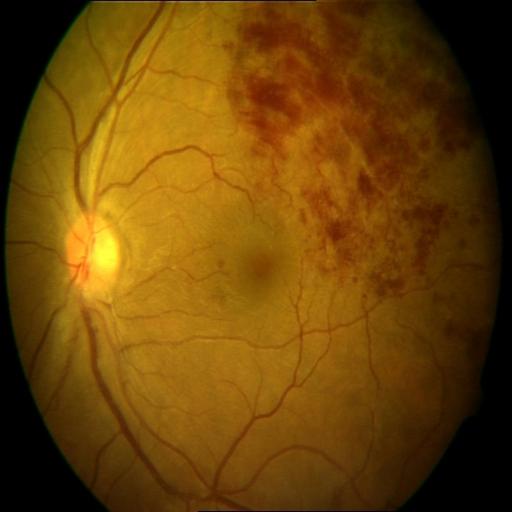 Findings: branch retinal vein occlusion.